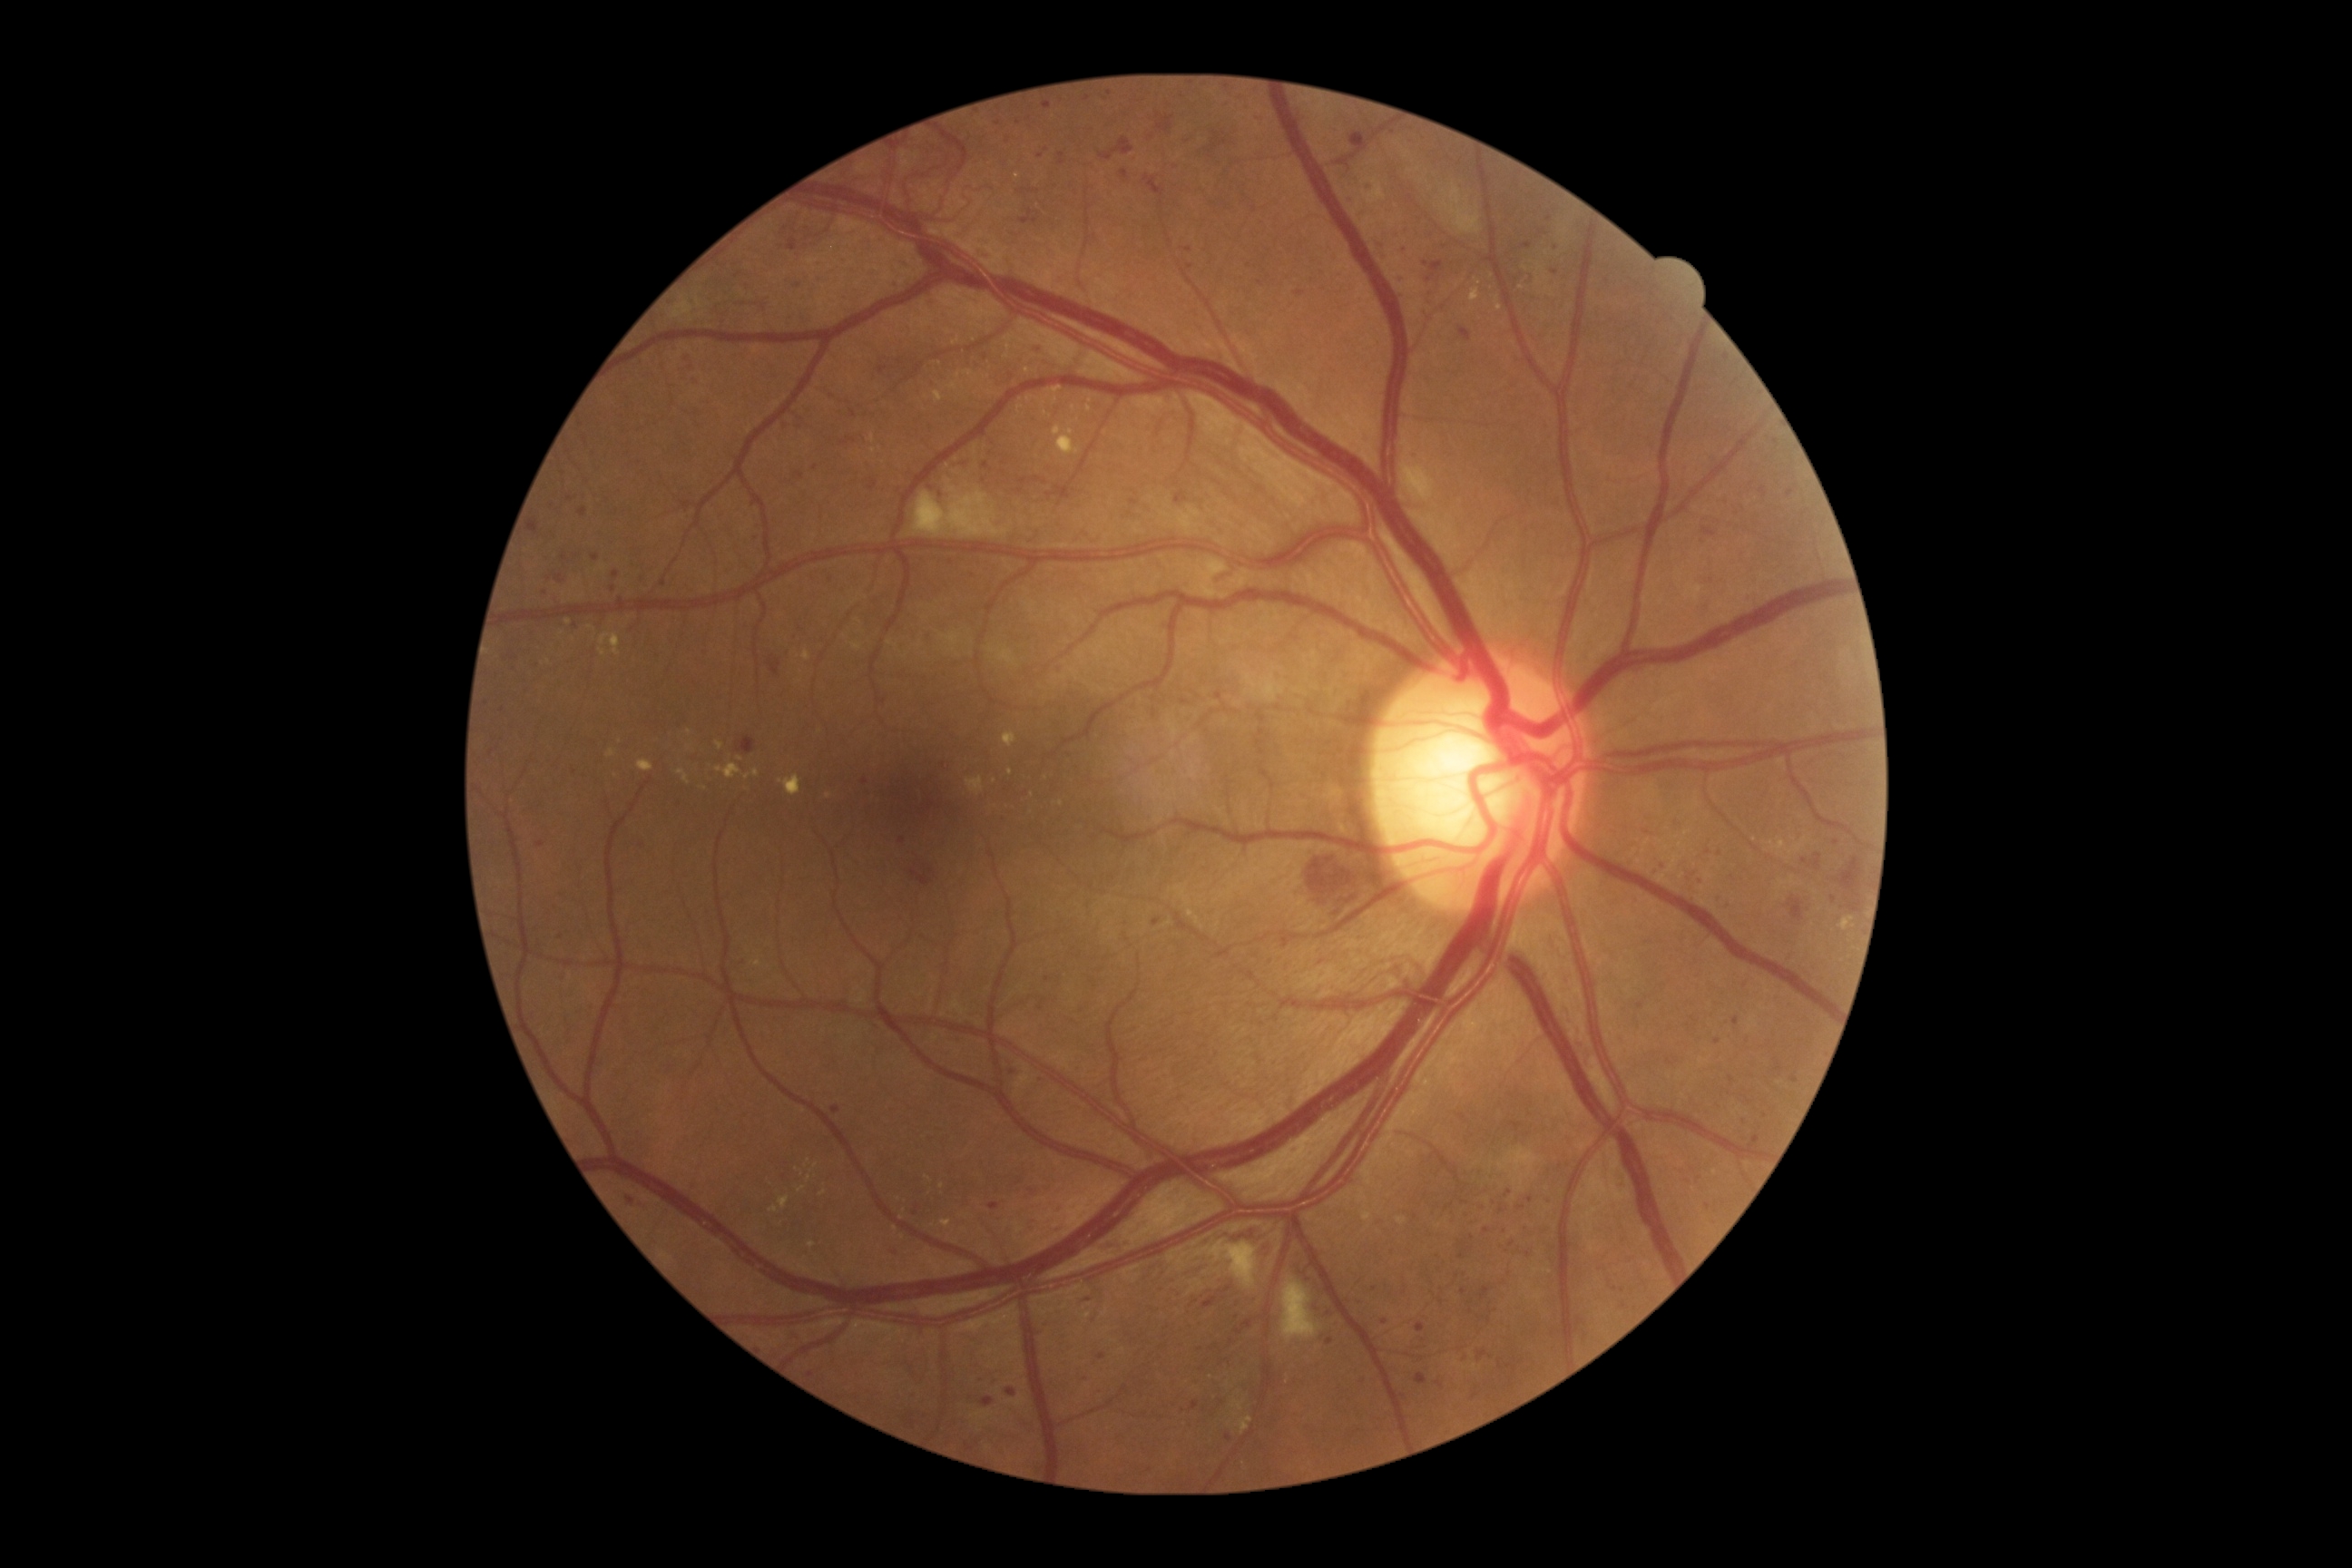

Diabetic retinopathy (DR) is grade 3.
Microaneurysms (MAs) are present, including at {"x1": 1084, "y1": 95, "x2": 1092, "y2": 101}, {"x1": 1661, "y1": 863, "x2": 1667, "y2": 872}, {"x1": 877, "y1": 366, "x2": 888, "y2": 375}, {"x1": 1175, "y1": 493, "x2": 1188, "y2": 504}, {"x1": 580, "y1": 507, "x2": 587, "y2": 518}, {"x1": 1732, "y1": 1017, "x2": 1740, "y2": 1026}, {"x1": 536, "y1": 843, "x2": 545, "y2": 848}, {"x1": 850, "y1": 411, "x2": 858, "y2": 418}, {"x1": 1026, "y1": 1217, "x2": 1034, "y2": 1230}, {"x1": 1349, "y1": 132, "x2": 1366, "y2": 144}, {"x1": 1378, "y1": 242, "x2": 1386, "y2": 246}, {"x1": 1043, "y1": 103, "x2": 1052, "y2": 110}.
MAs (small, approximate centers) near Point(1707, 1207), Point(1464, 1292), Point(1089, 1300), Point(1475, 1396), Point(900, 363), Point(1836, 843), Point(1257, 117).
Hard exudates (EXs) are present, including at {"x1": 870, "y1": 435, "x2": 876, "y2": 444}, {"x1": 808, "y1": 1242, "x2": 816, "y2": 1250}, {"x1": 607, "y1": 750, "x2": 618, "y2": 760}, {"x1": 1052, "y1": 387, "x2": 1063, "y2": 395}, {"x1": 779, "y1": 776, "x2": 801, "y2": 796}, {"x1": 796, "y1": 1168, "x2": 805, "y2": 1177}, {"x1": 638, "y1": 760, "x2": 654, "y2": 772}, {"x1": 934, "y1": 391, "x2": 945, "y2": 404}.
EXs (small, approximate centers) near Point(816, 1166), Point(1016, 176), Point(802, 1189), Point(1541, 268), Point(943, 1186), Point(902, 1218), Point(824, 1194), Point(1522, 288), Point(1244, 1463).